1924 x 1556 pixels
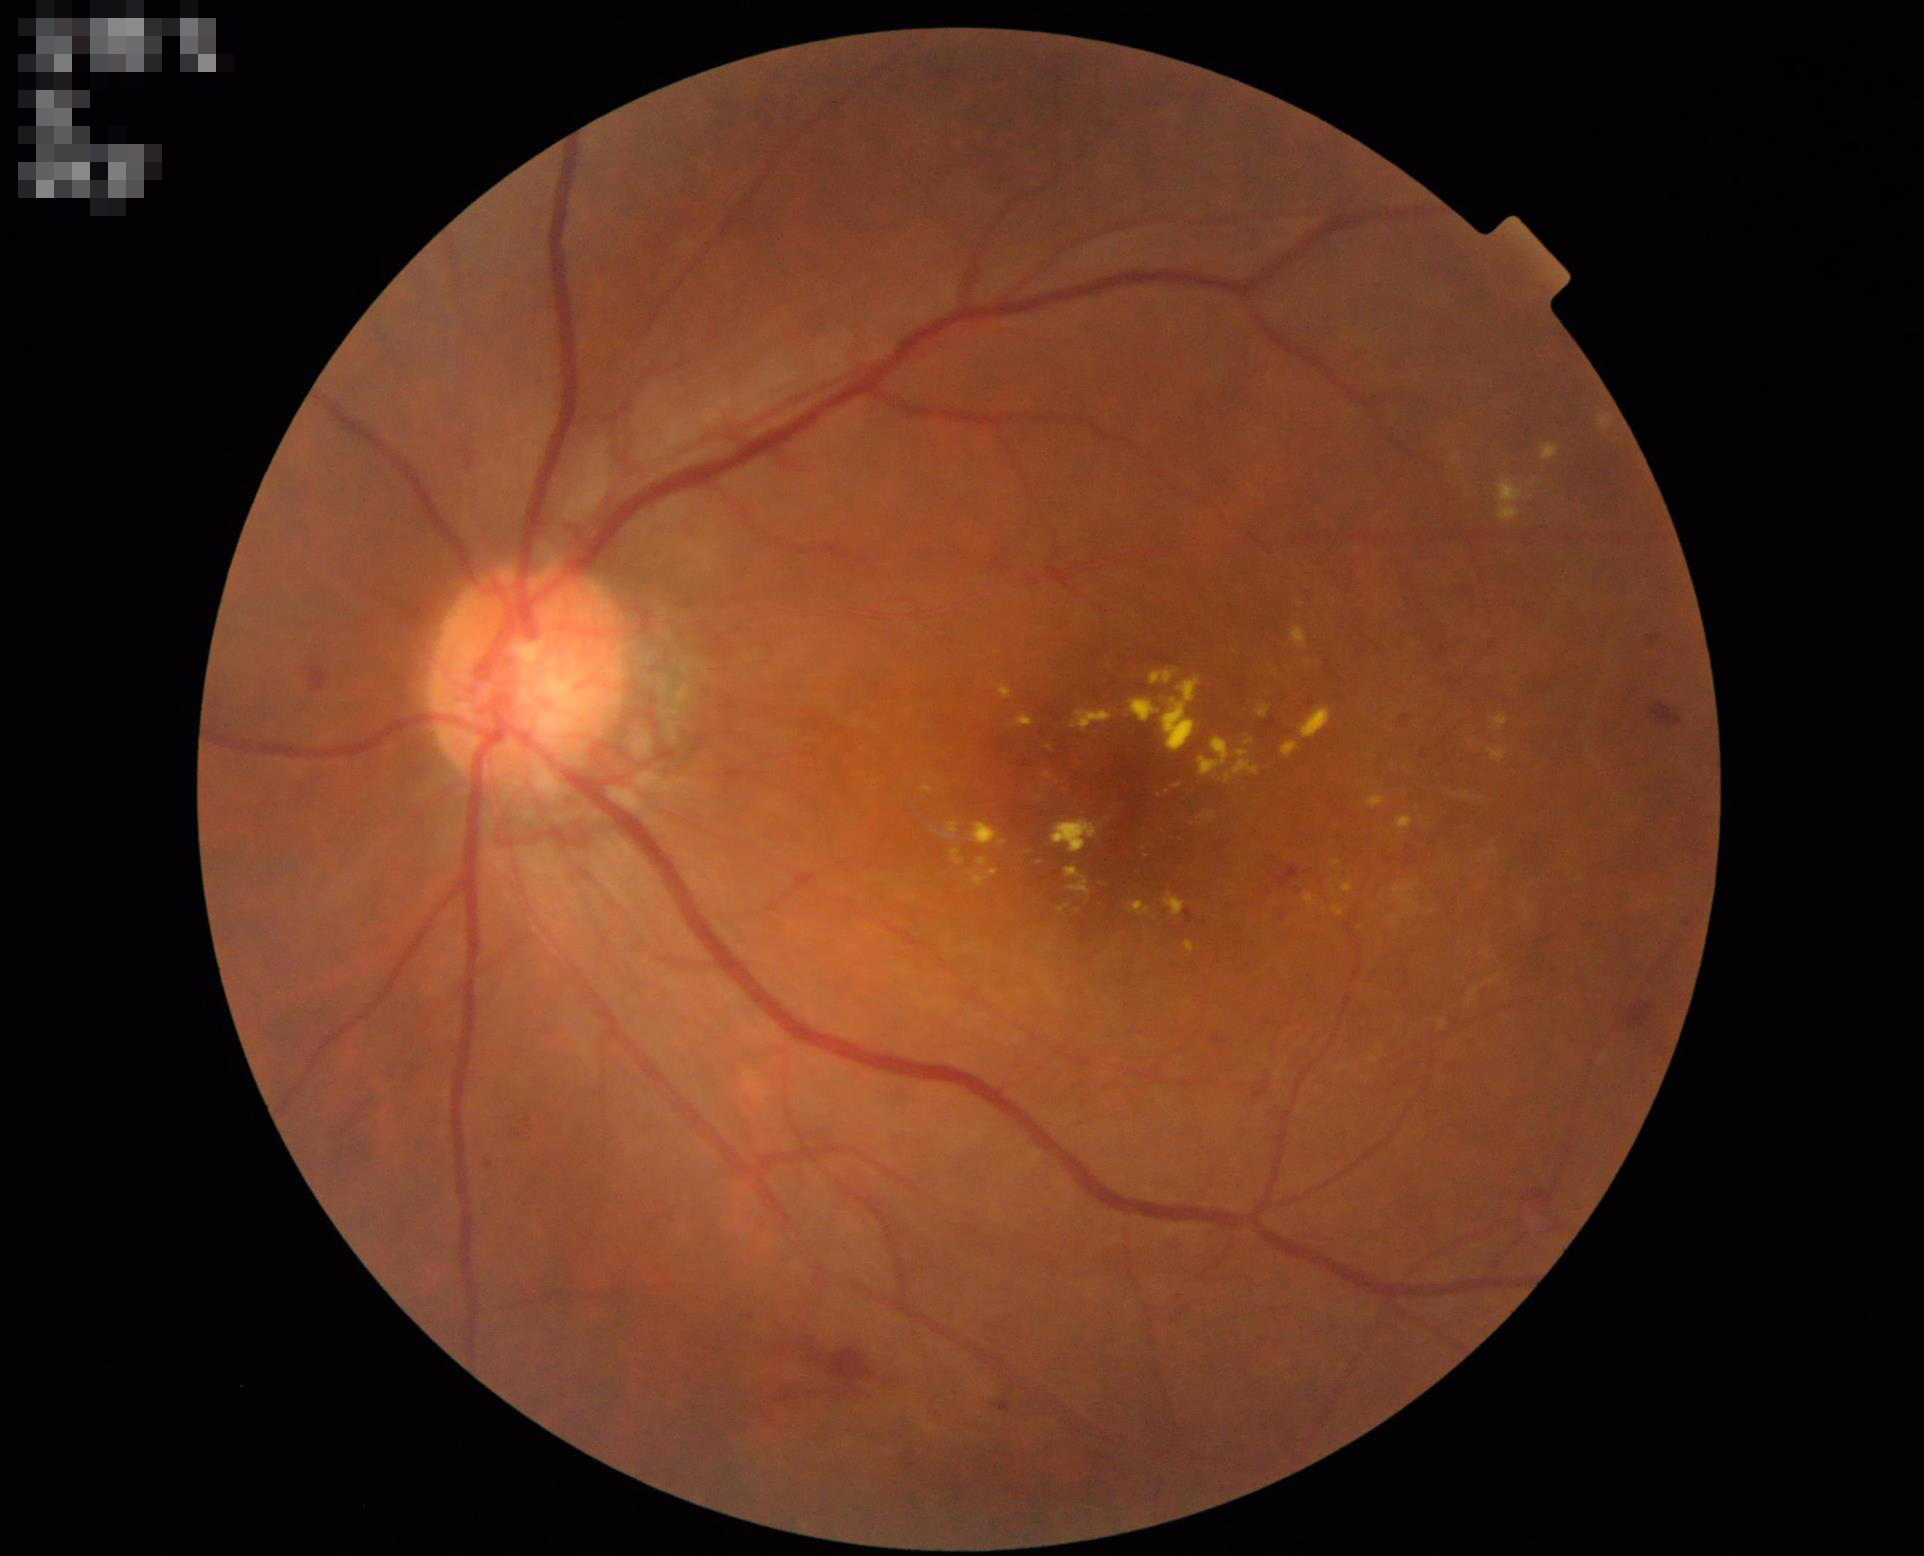

Overall image quality = good; Contrast = adequate; Illumination/color = good.